1440 x 1080 pixels · acquired on the Natus RetCam Envision · pediatric wide-field fundus photograph
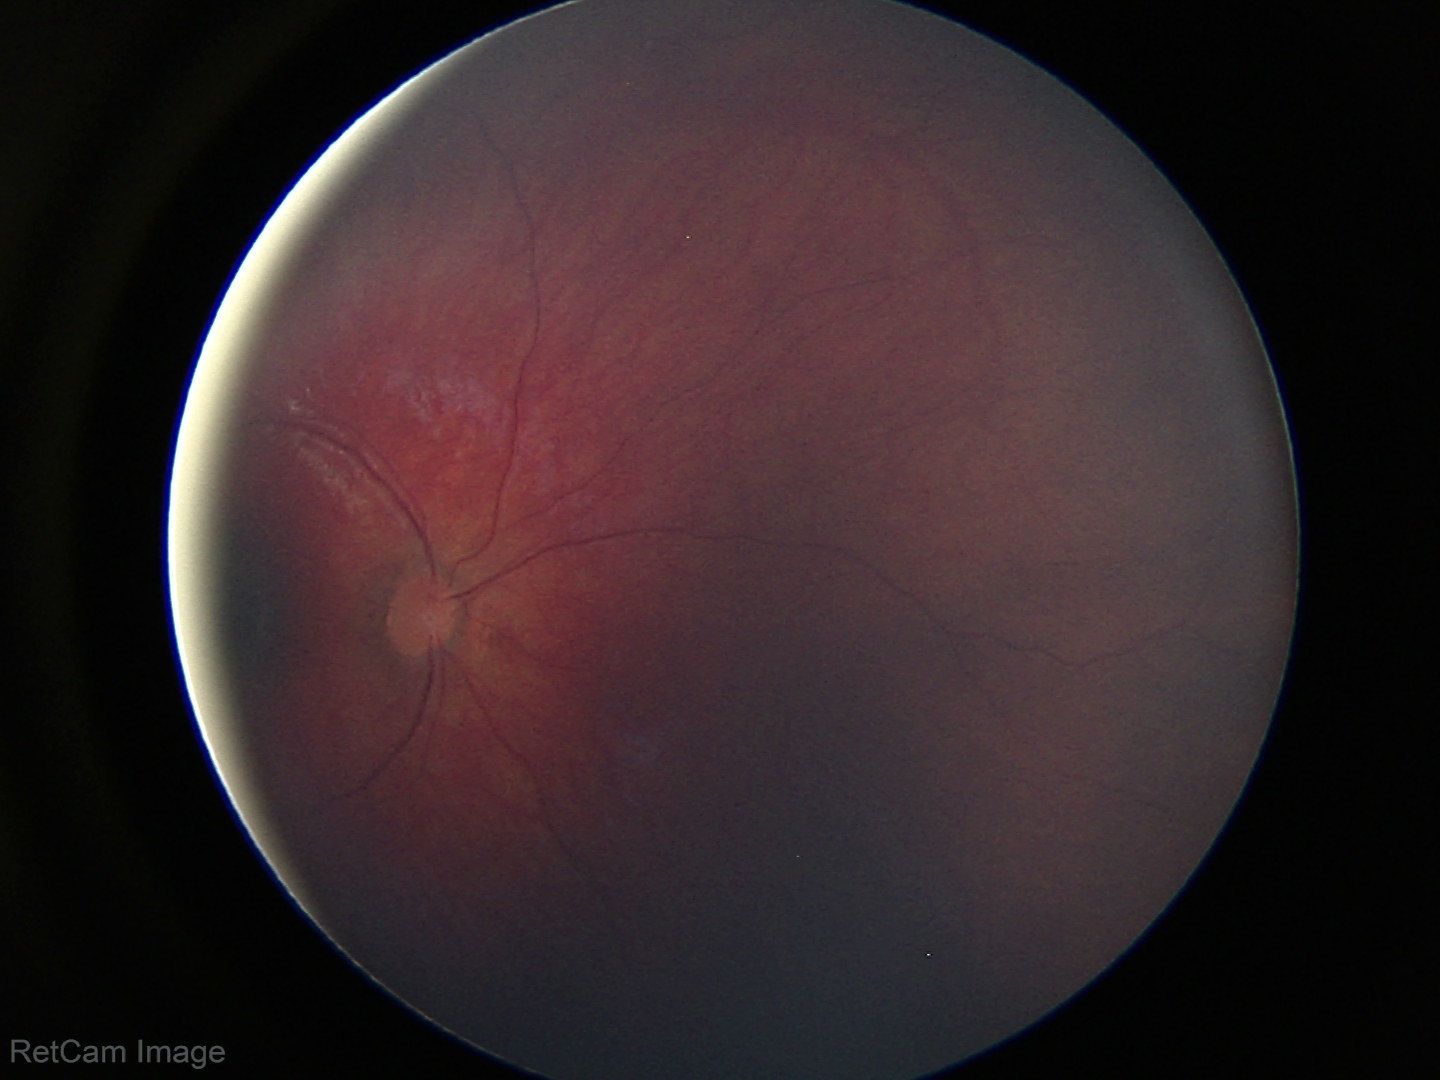 Assessment = normal retinal appearance.